Nonmydriatic fundus photograph, graded on the modified Davis scale
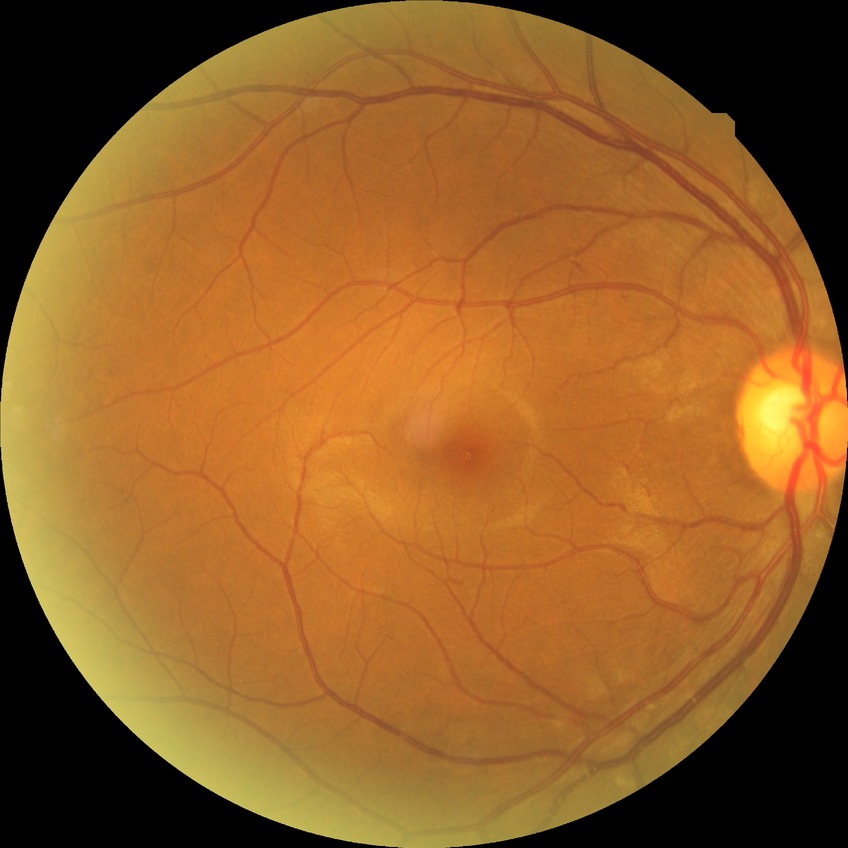 retinopathy grade=simple diabetic retinopathy.